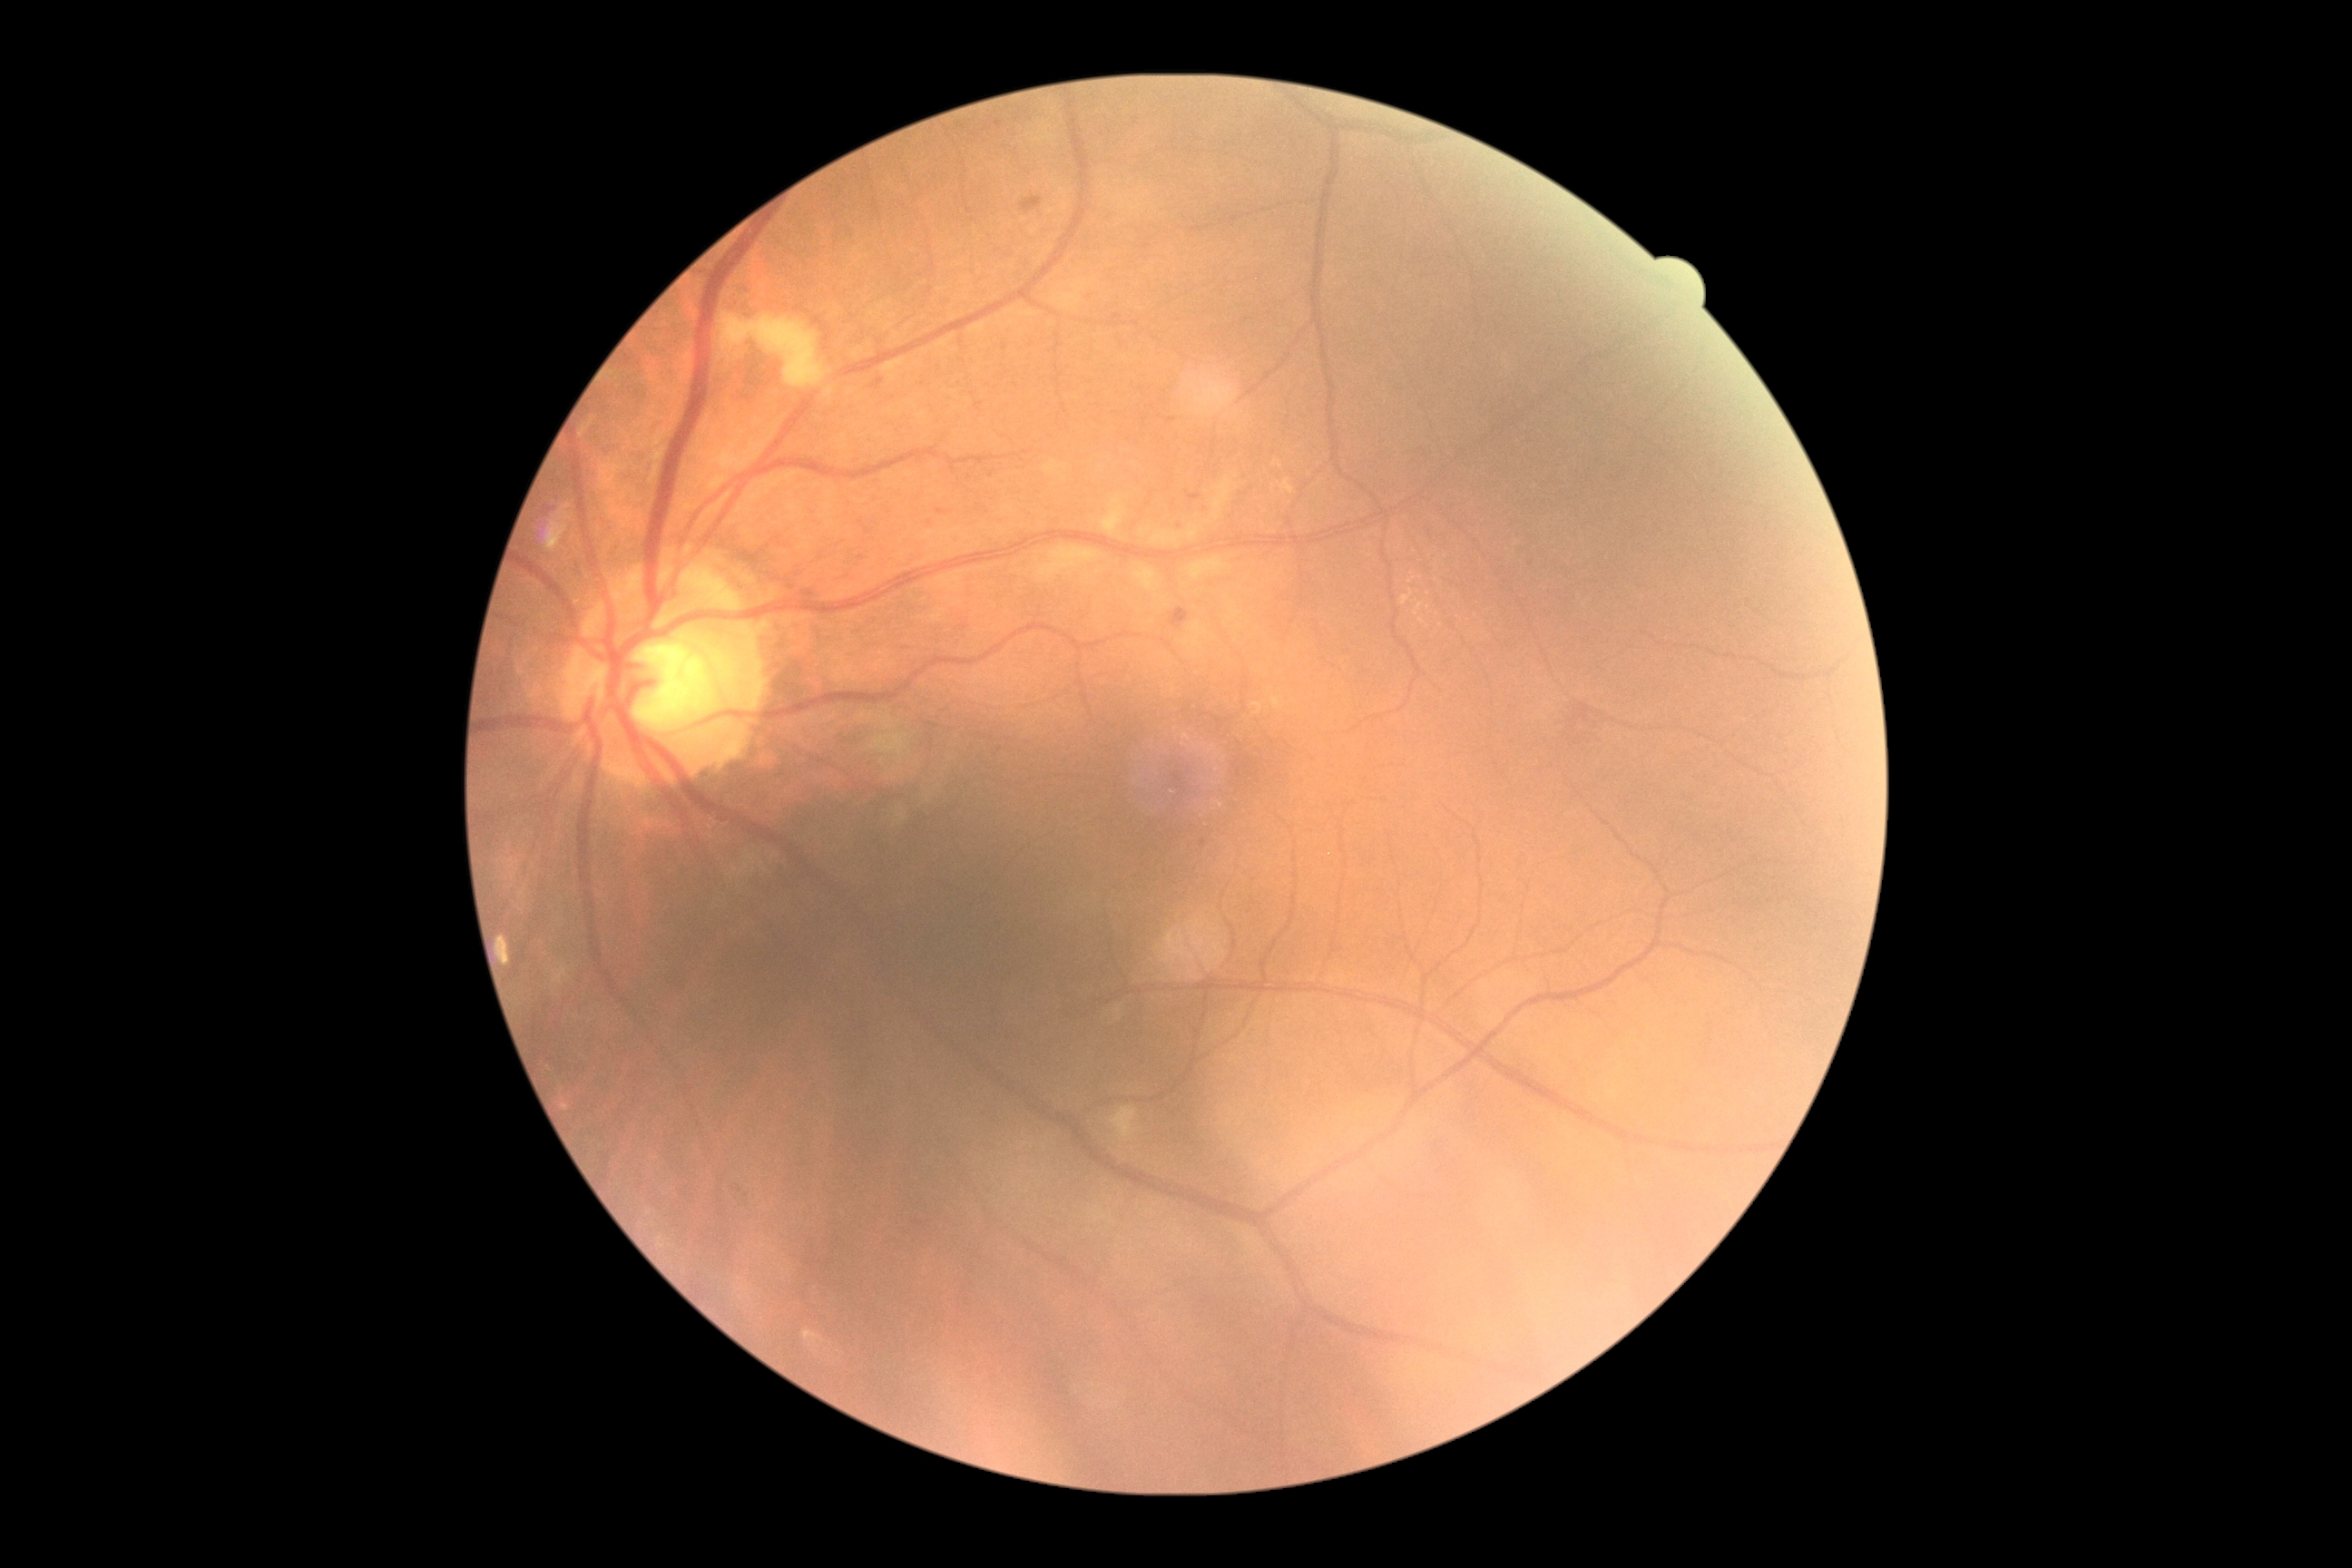 Diabetic retinopathy severity is 2/4.